Pediatric retinal photograph (wide-field); 1440 x 1080 pixels:
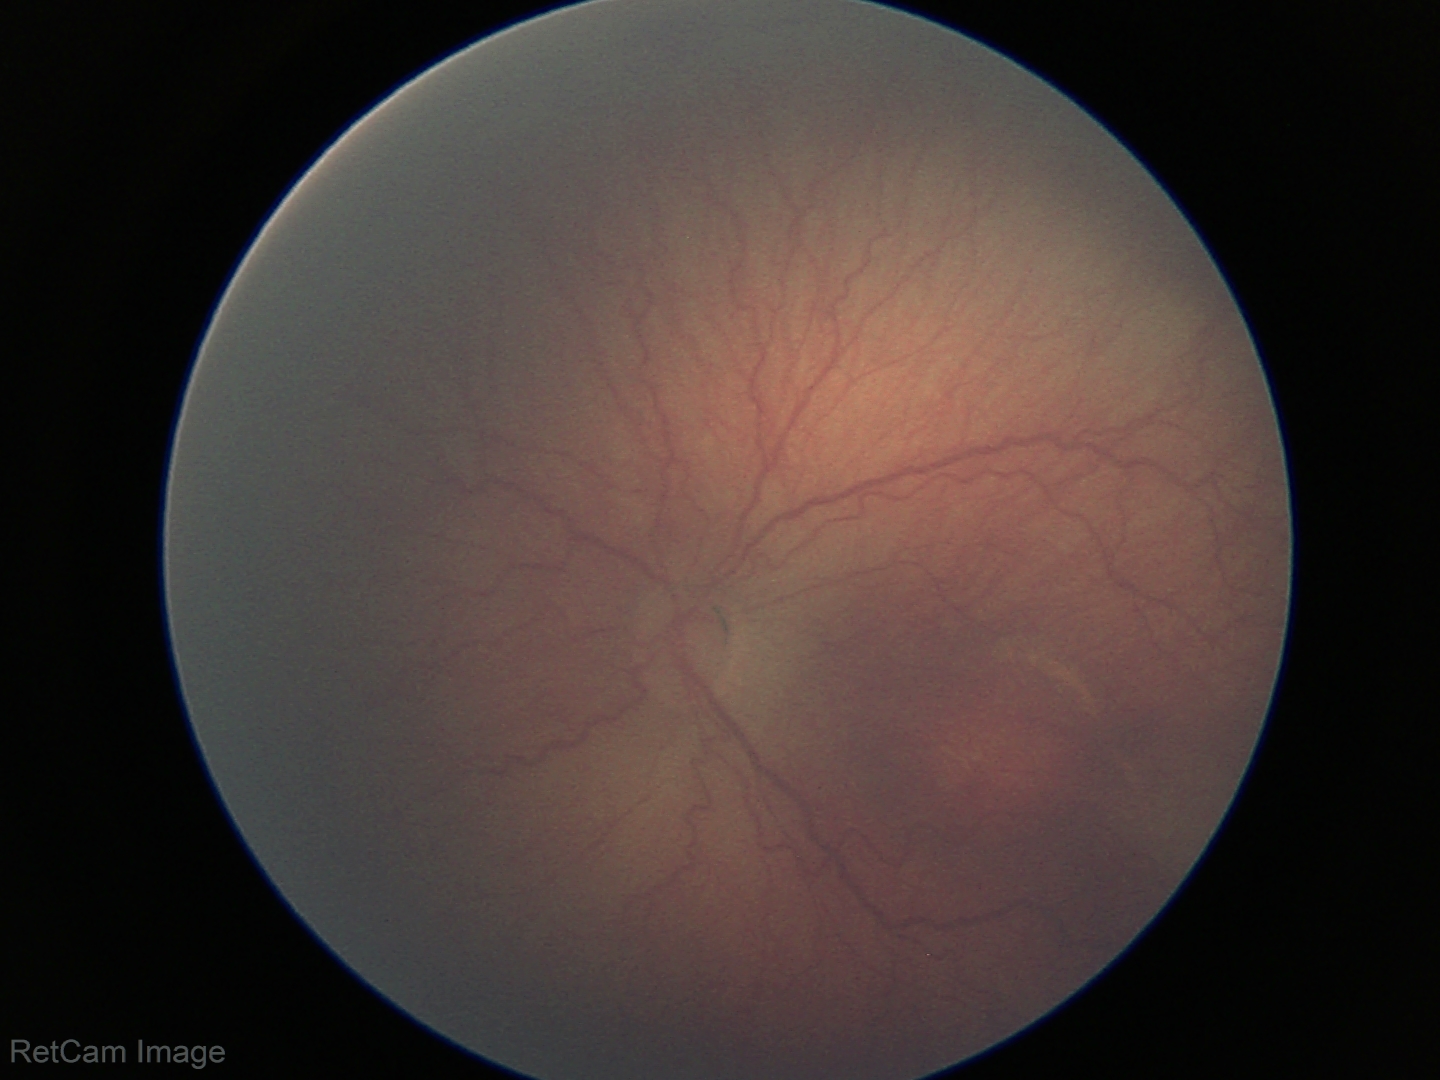 Screening examination consistent with retinopathy of prematurity stage 2 — ridge with height and width at the demarcation line. No plus disease.